45° FOV.
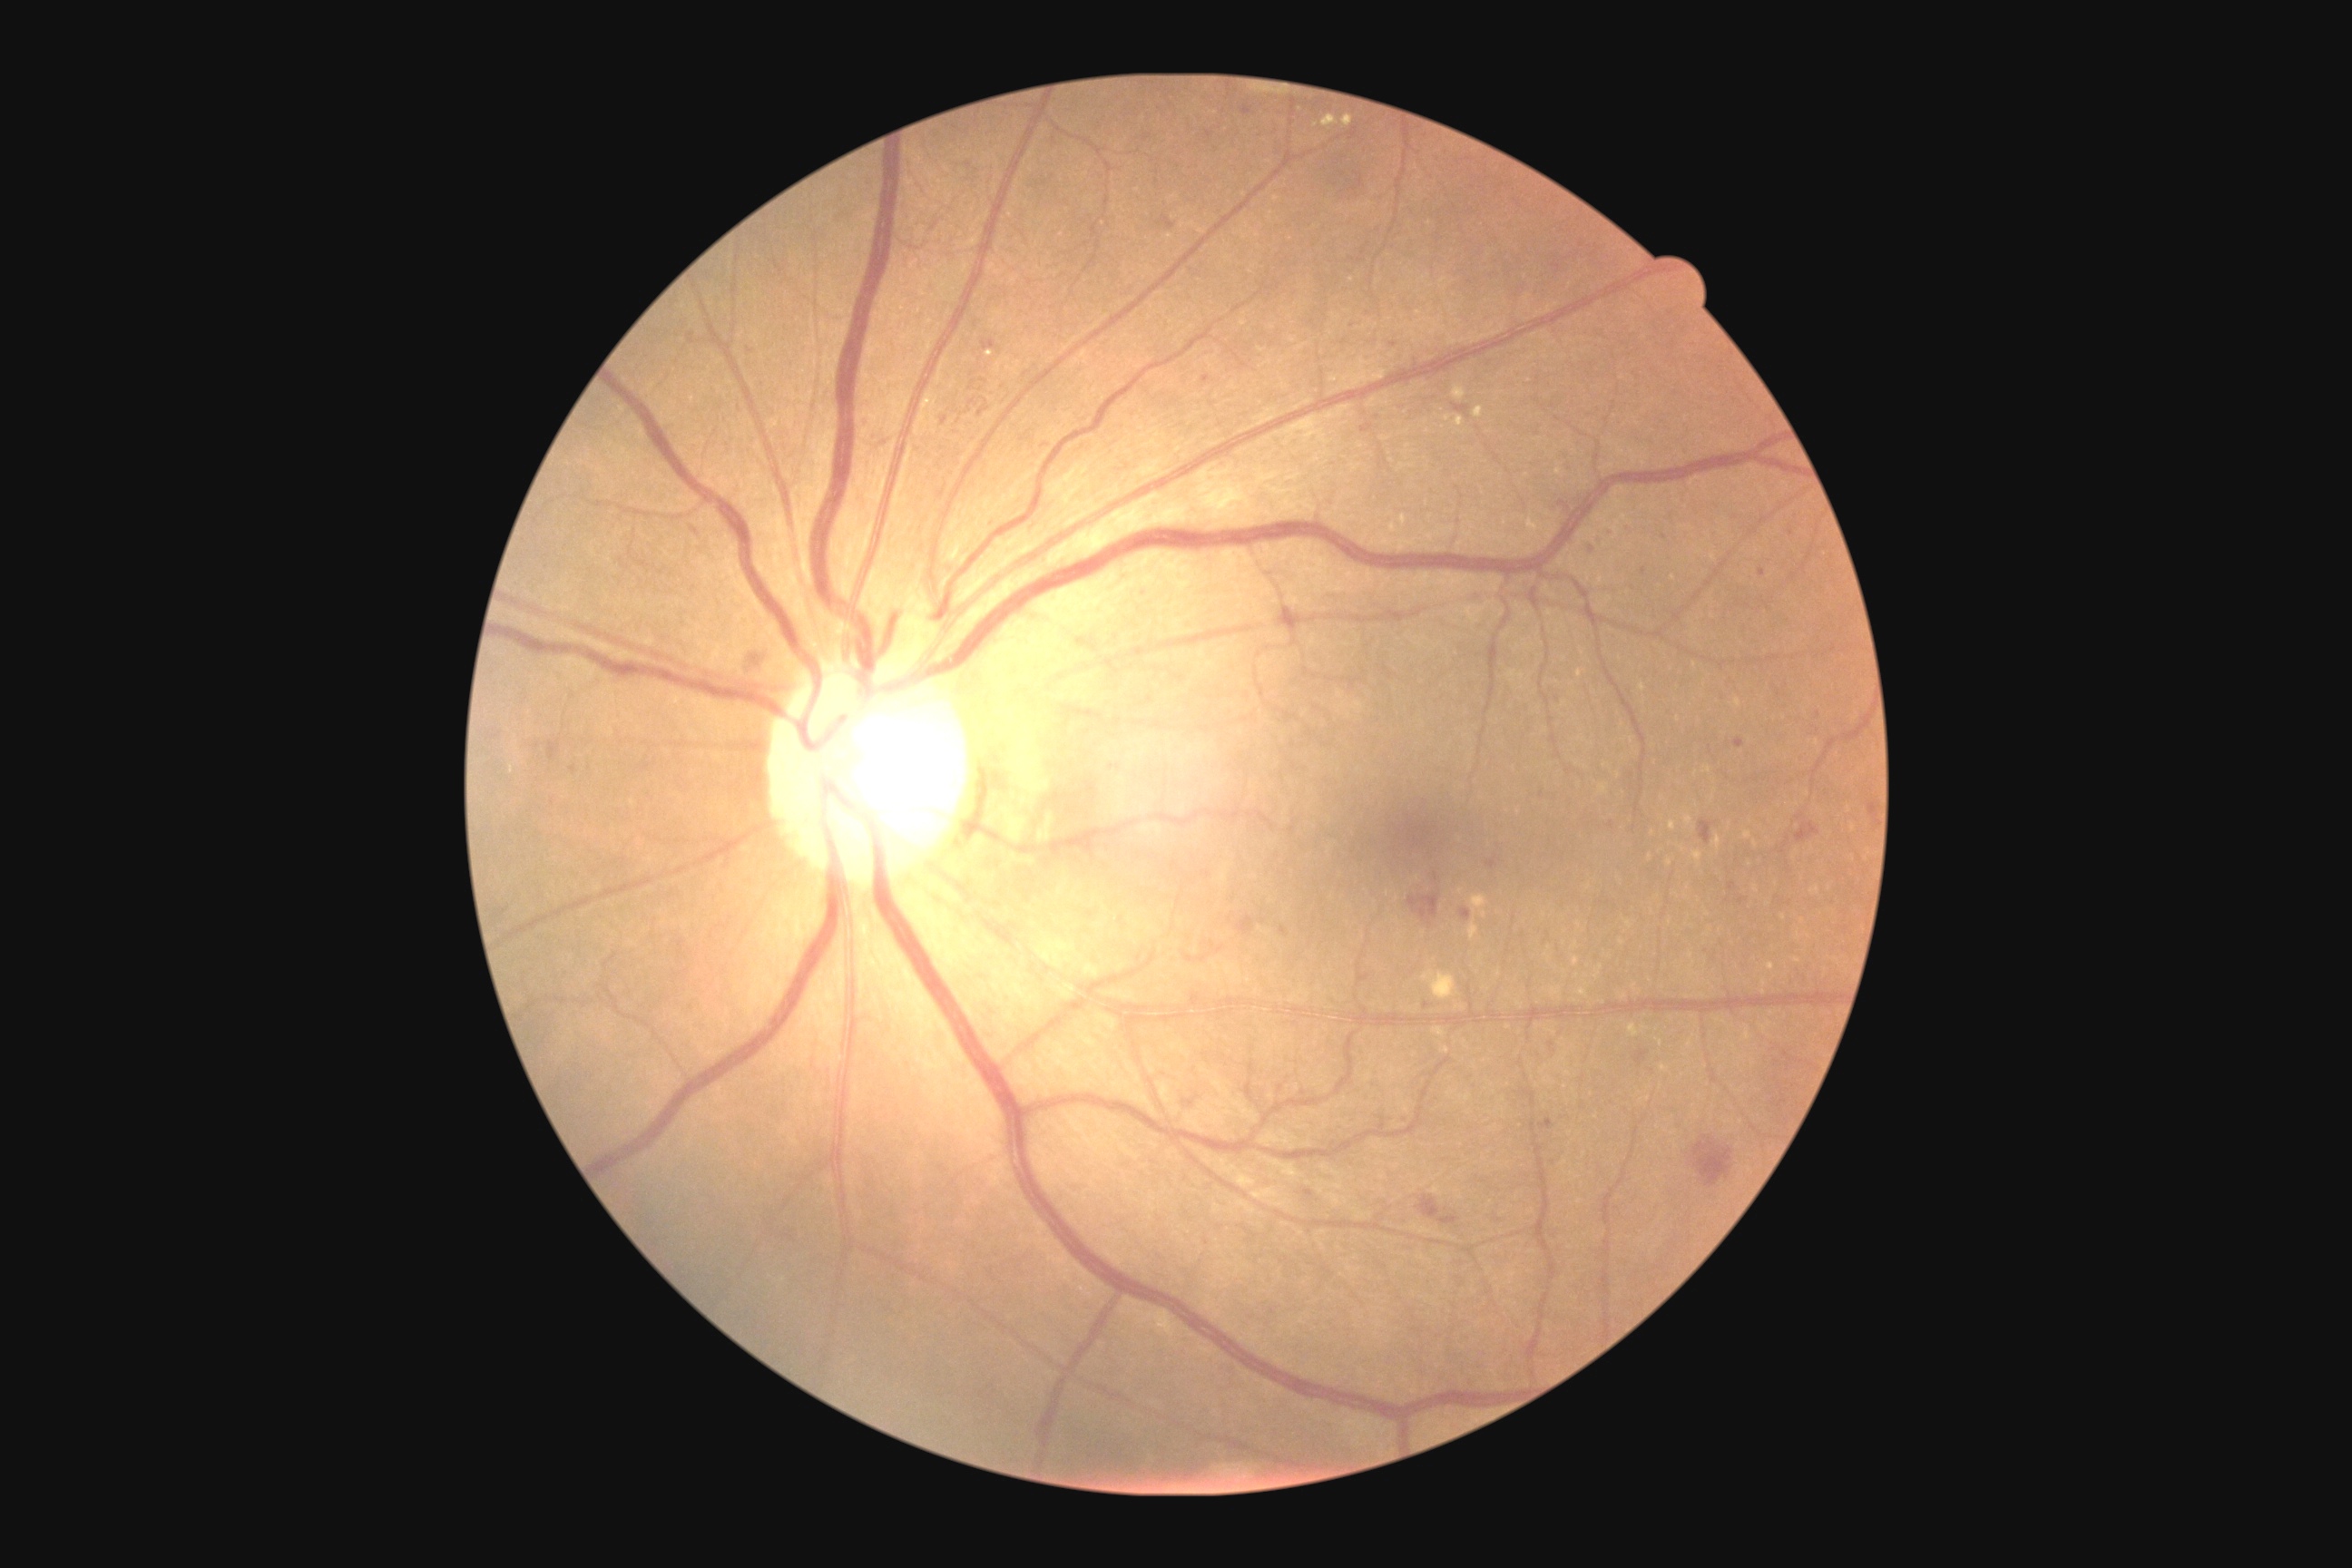

DR is moderate non-proliferative diabetic retinopathy (grade 2).
HEs include (1402,1115,1407,1124); (1362,424,1373,433); (1202,377,1211,384); (1409,894,1440,926); (1710,533,1720,542); (547,741,560,761); (1796,823,1821,843); (1807,730,1821,738); (1237,916,1255,936); (1607,529,1614,538); (1460,910,1471,921); (856,418,868,429).
Small HEs approximately at point(1367, 314); point(1046, 445); point(1471, 283); point(1436, 877); point(573, 770); point(1344, 342); point(1389, 1118); point(1592, 550).